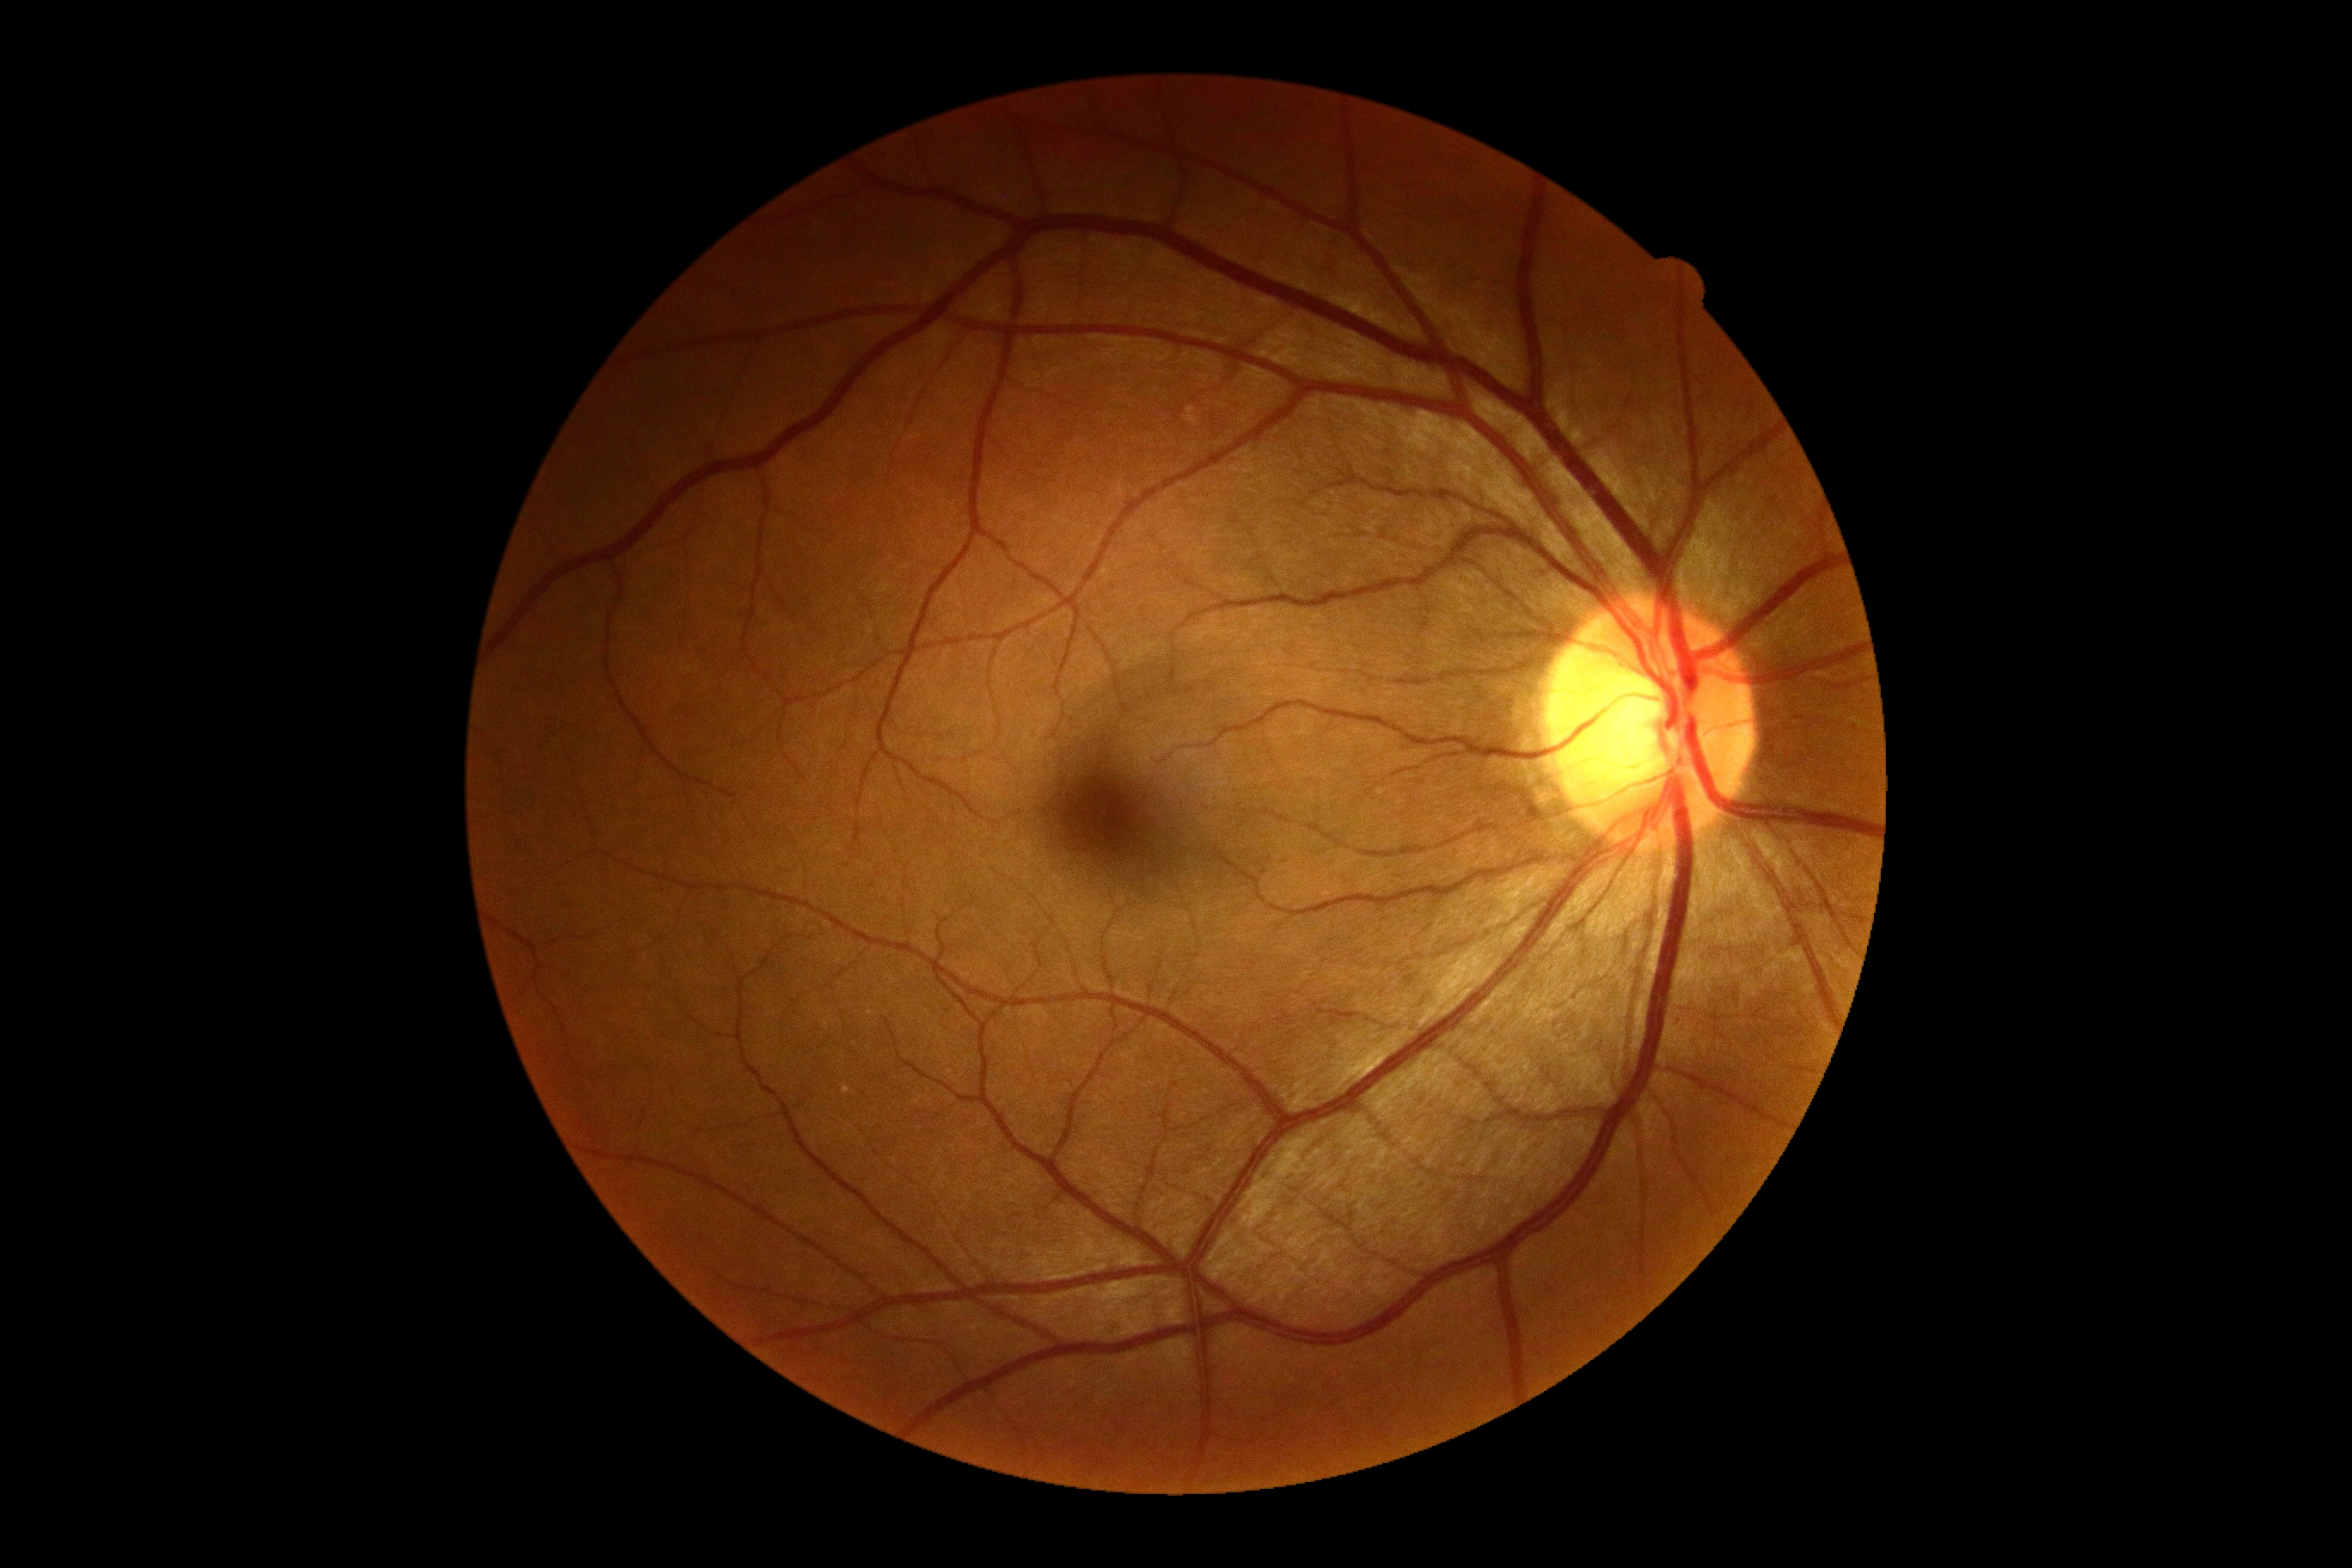 Annotations:
– DR — grade 0 (no apparent retinopathy)
– DR impression — no DR findings